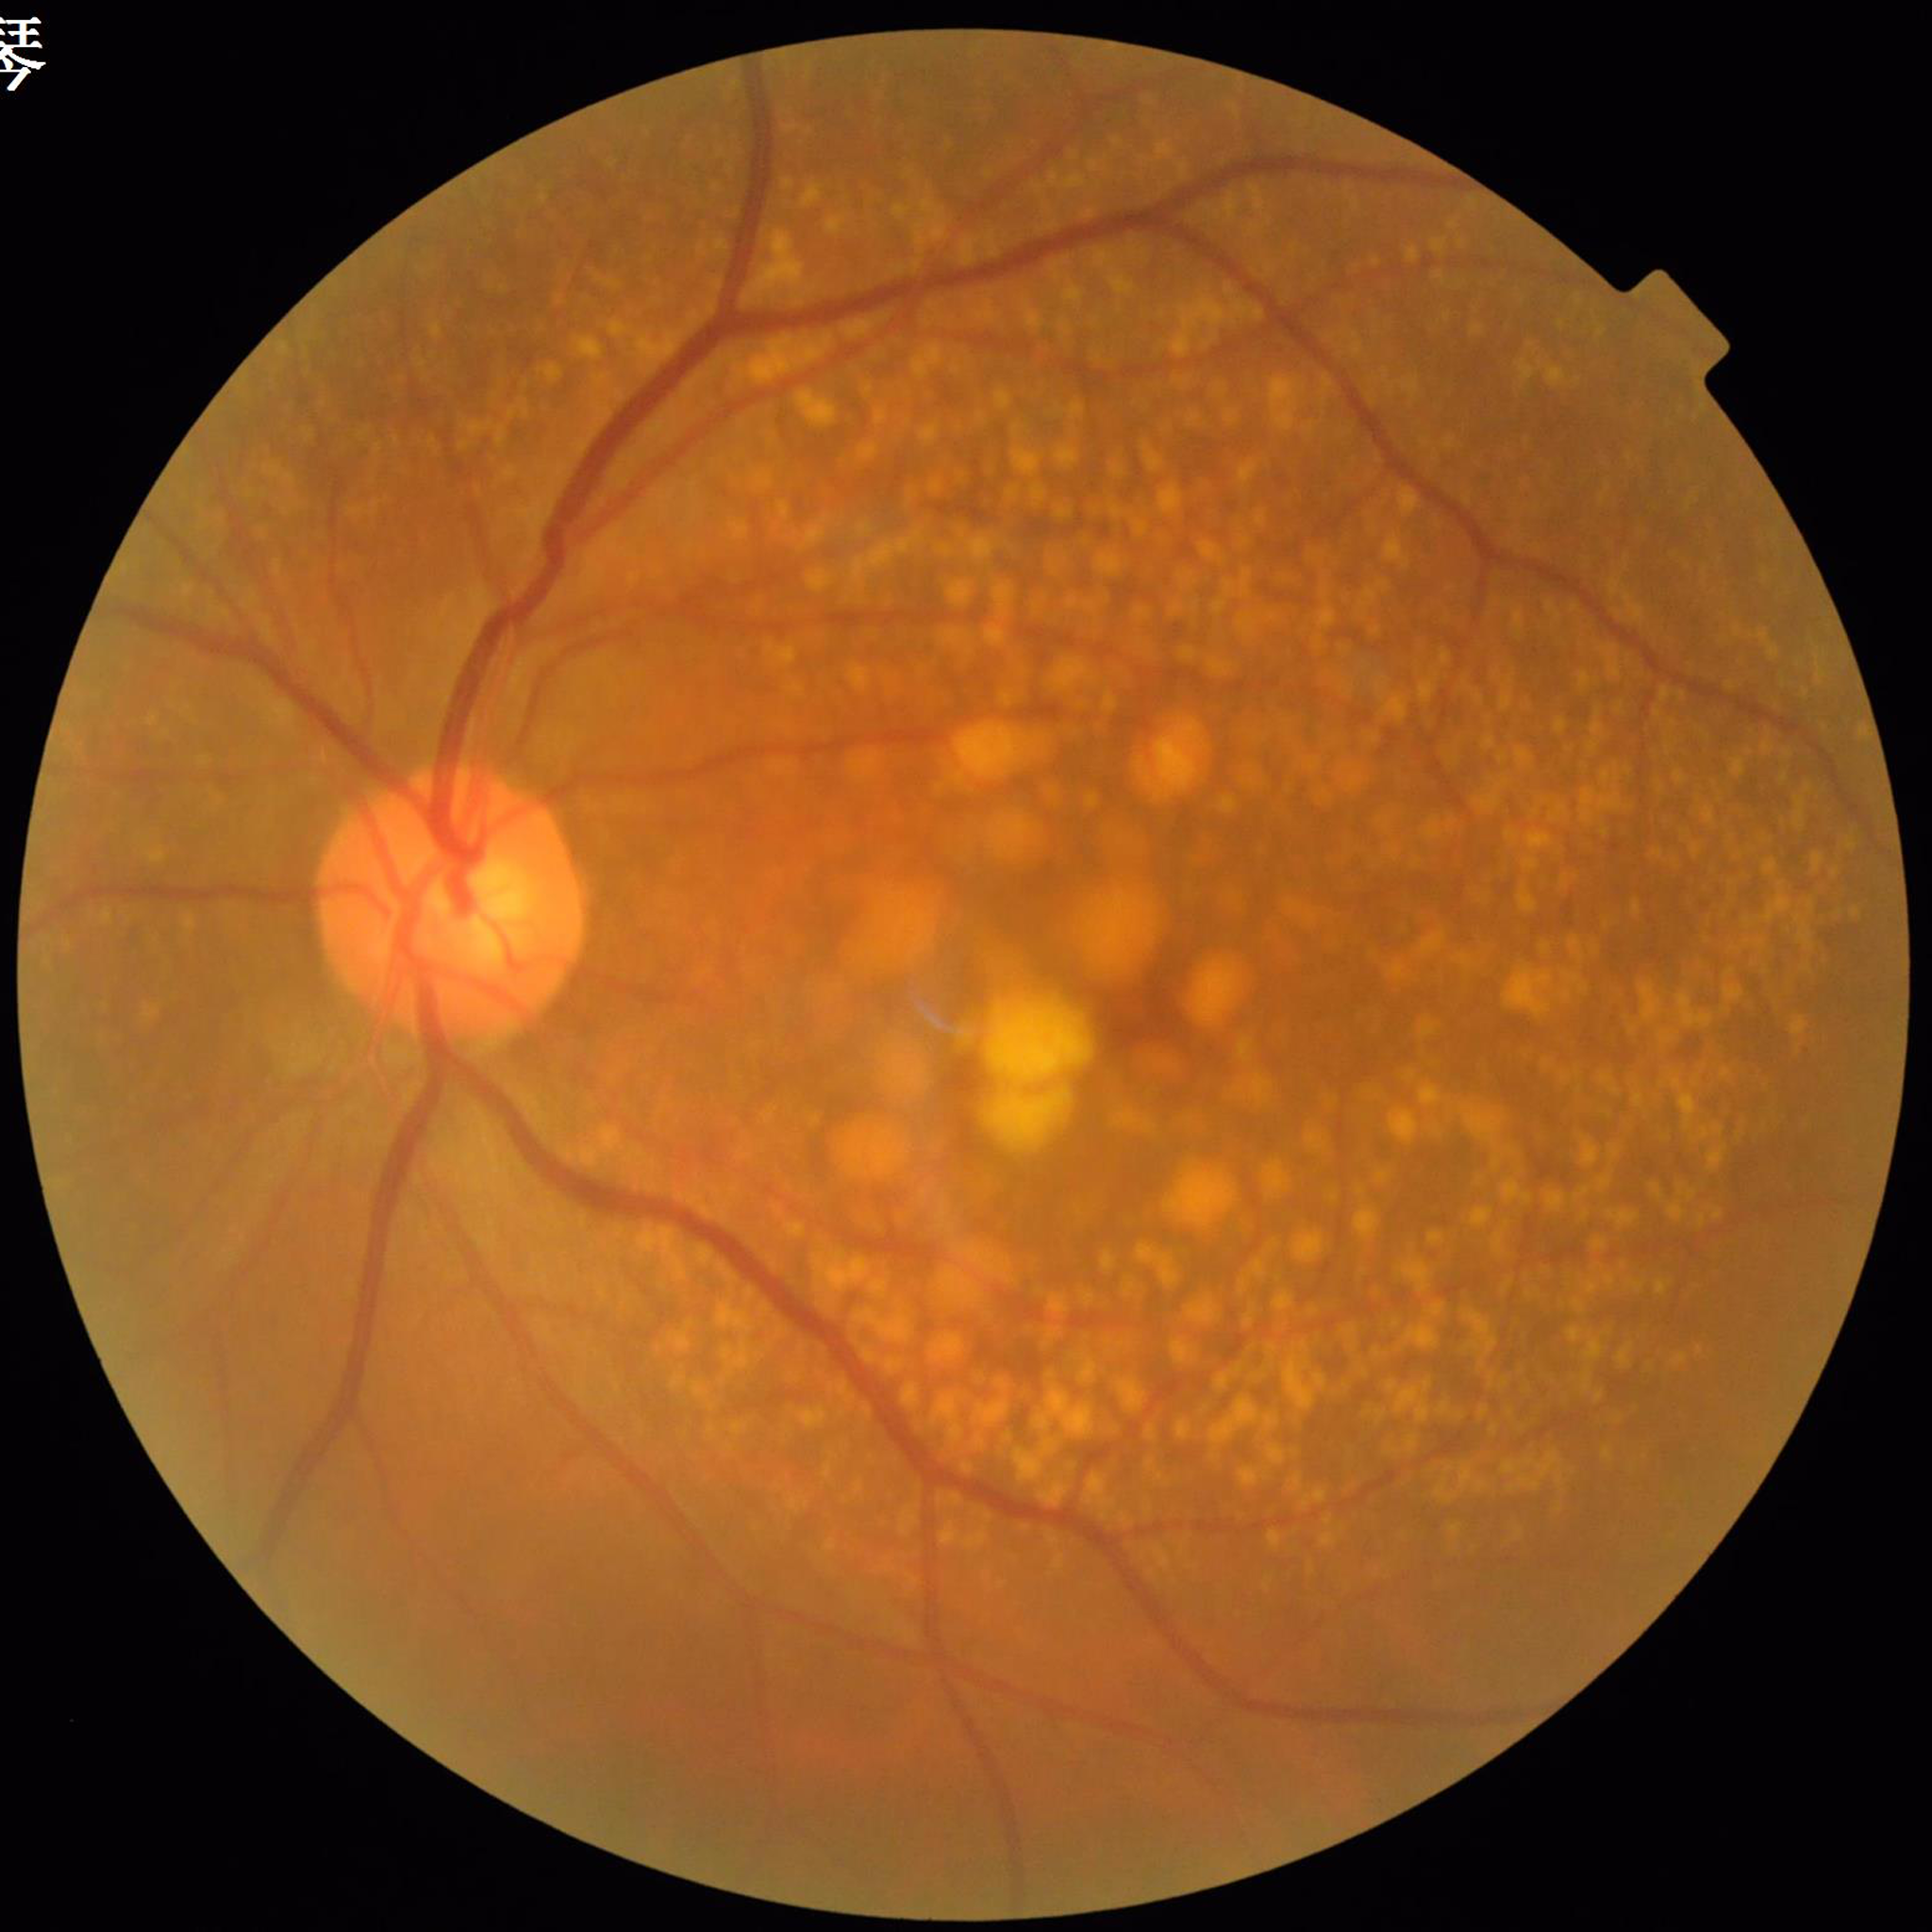 The patient was diagnosed with age-related macular degeneration (AMD).